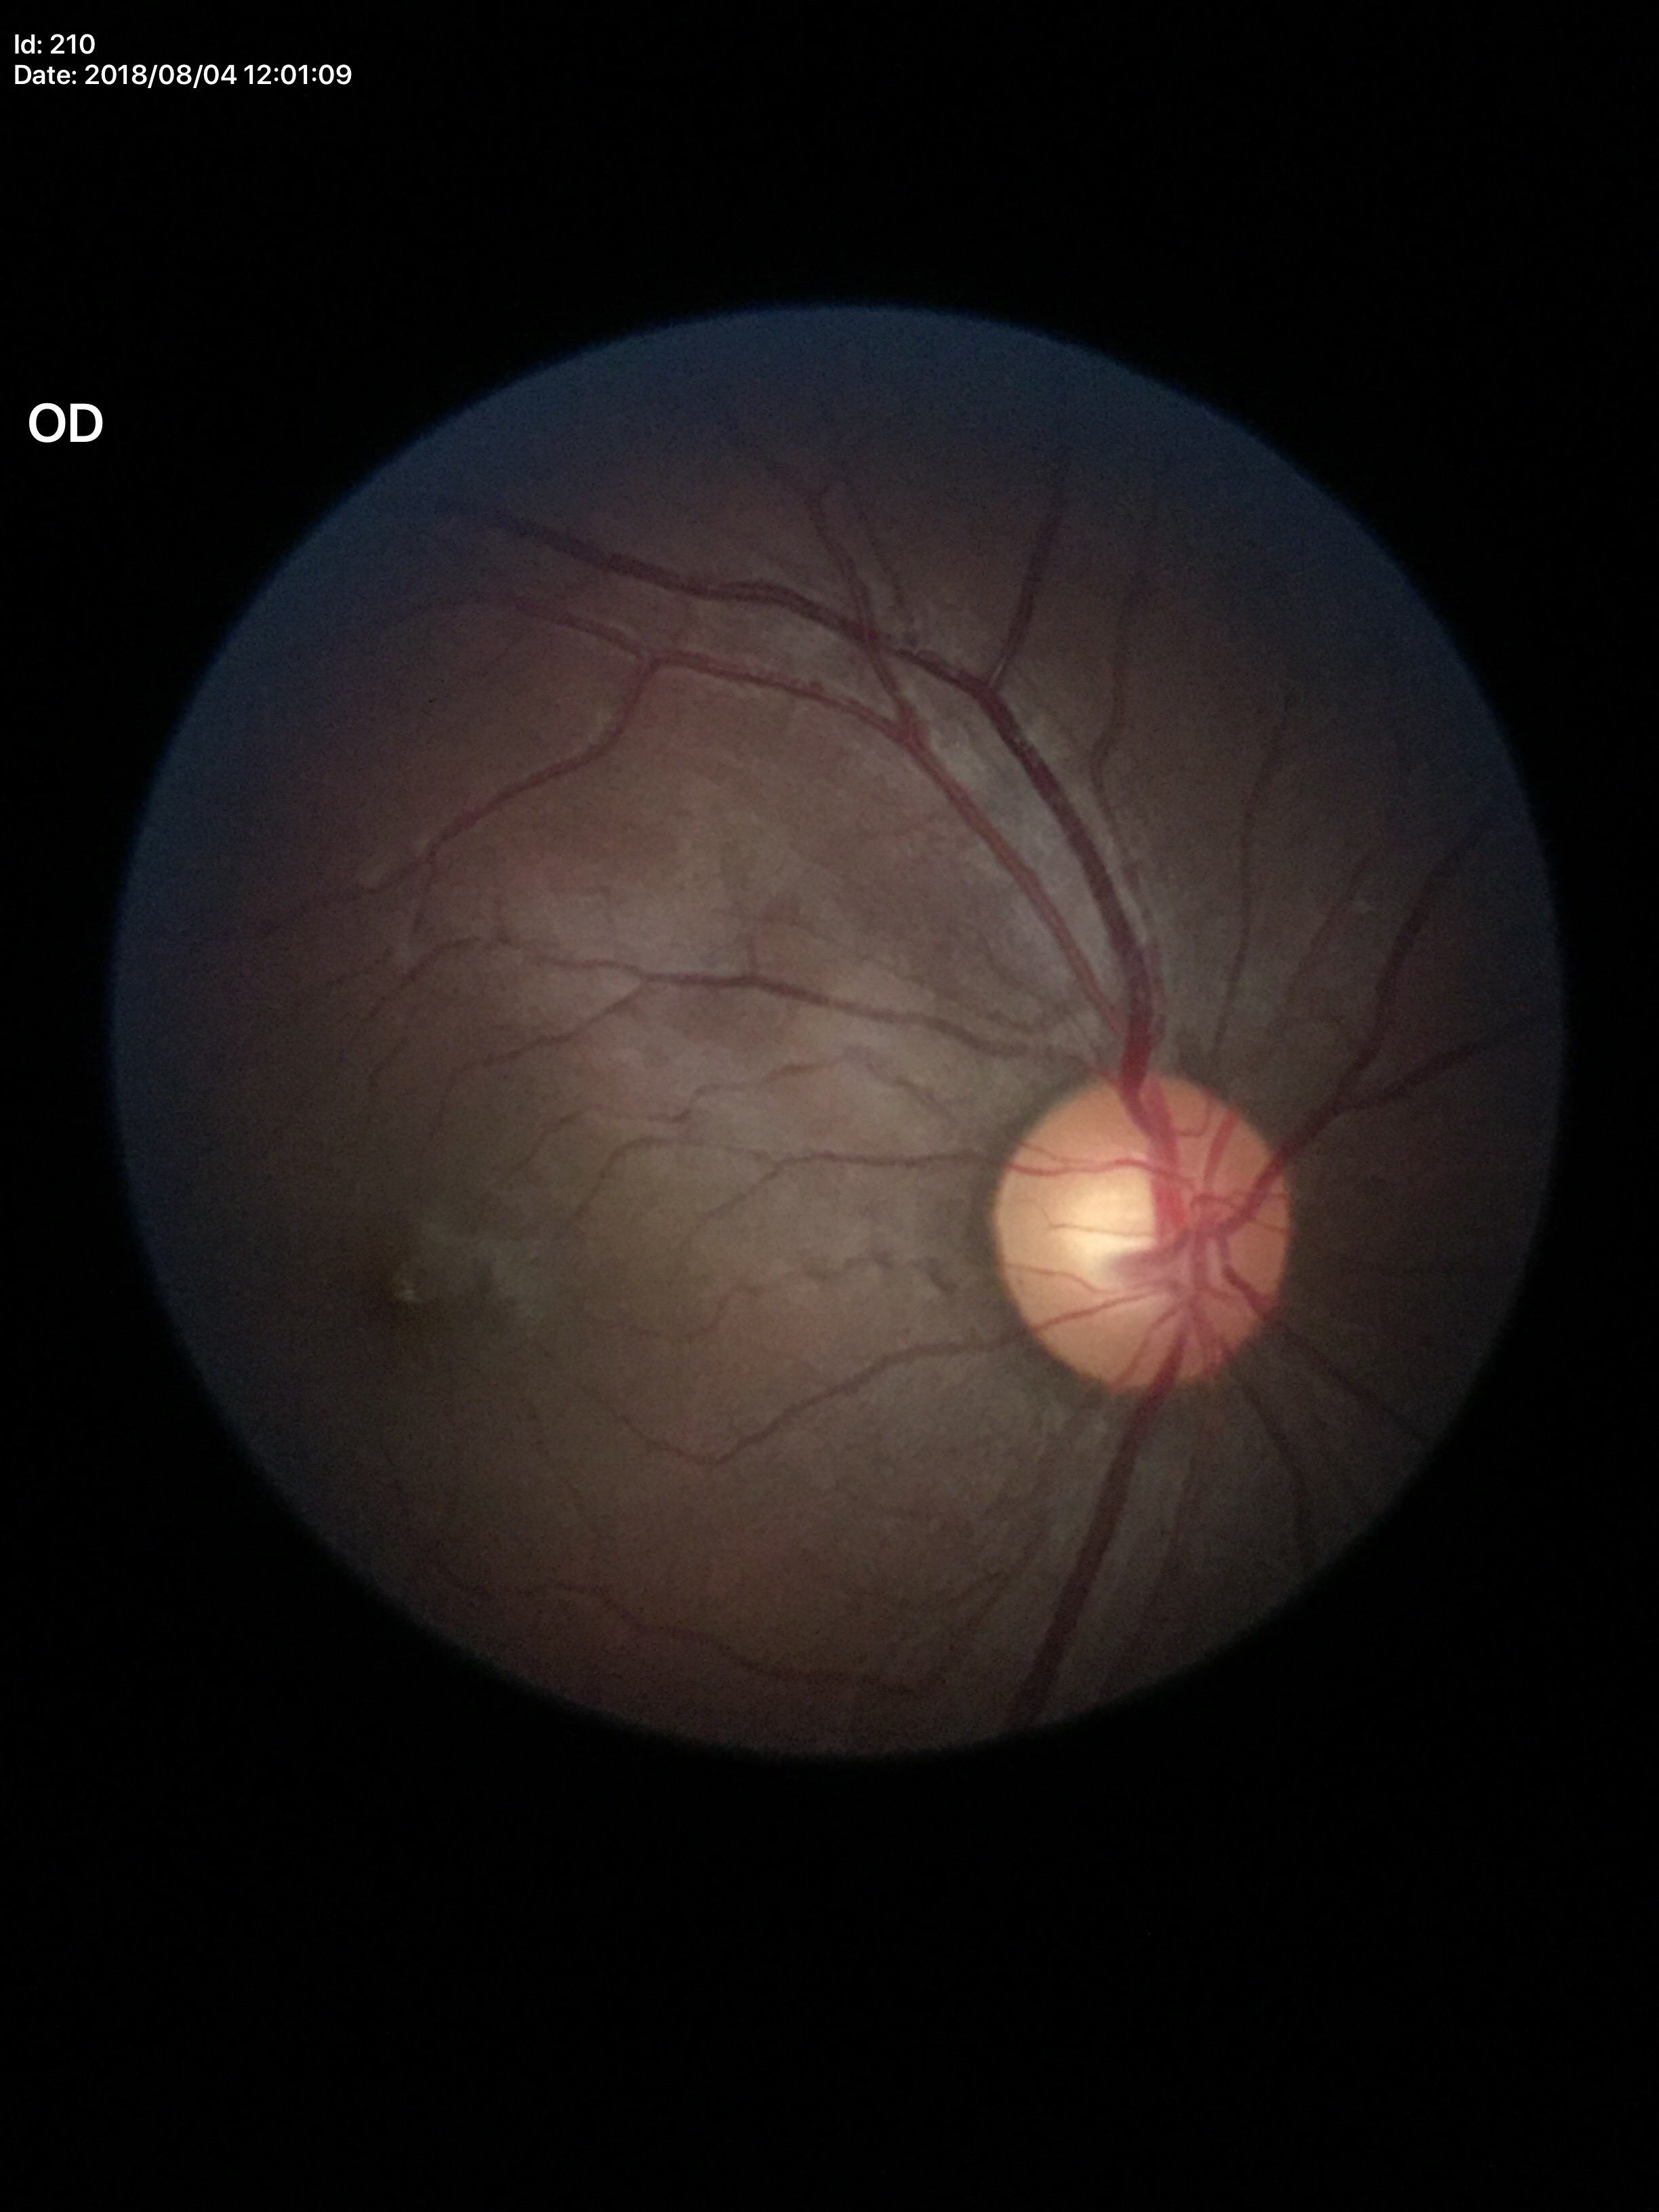 Findings:
• Glaucoma assessment — no suspicious findings
• VCDR — 0.54